Retinal fundus photograph; FOV: 45 degrees; 2352 x 1568 pixels
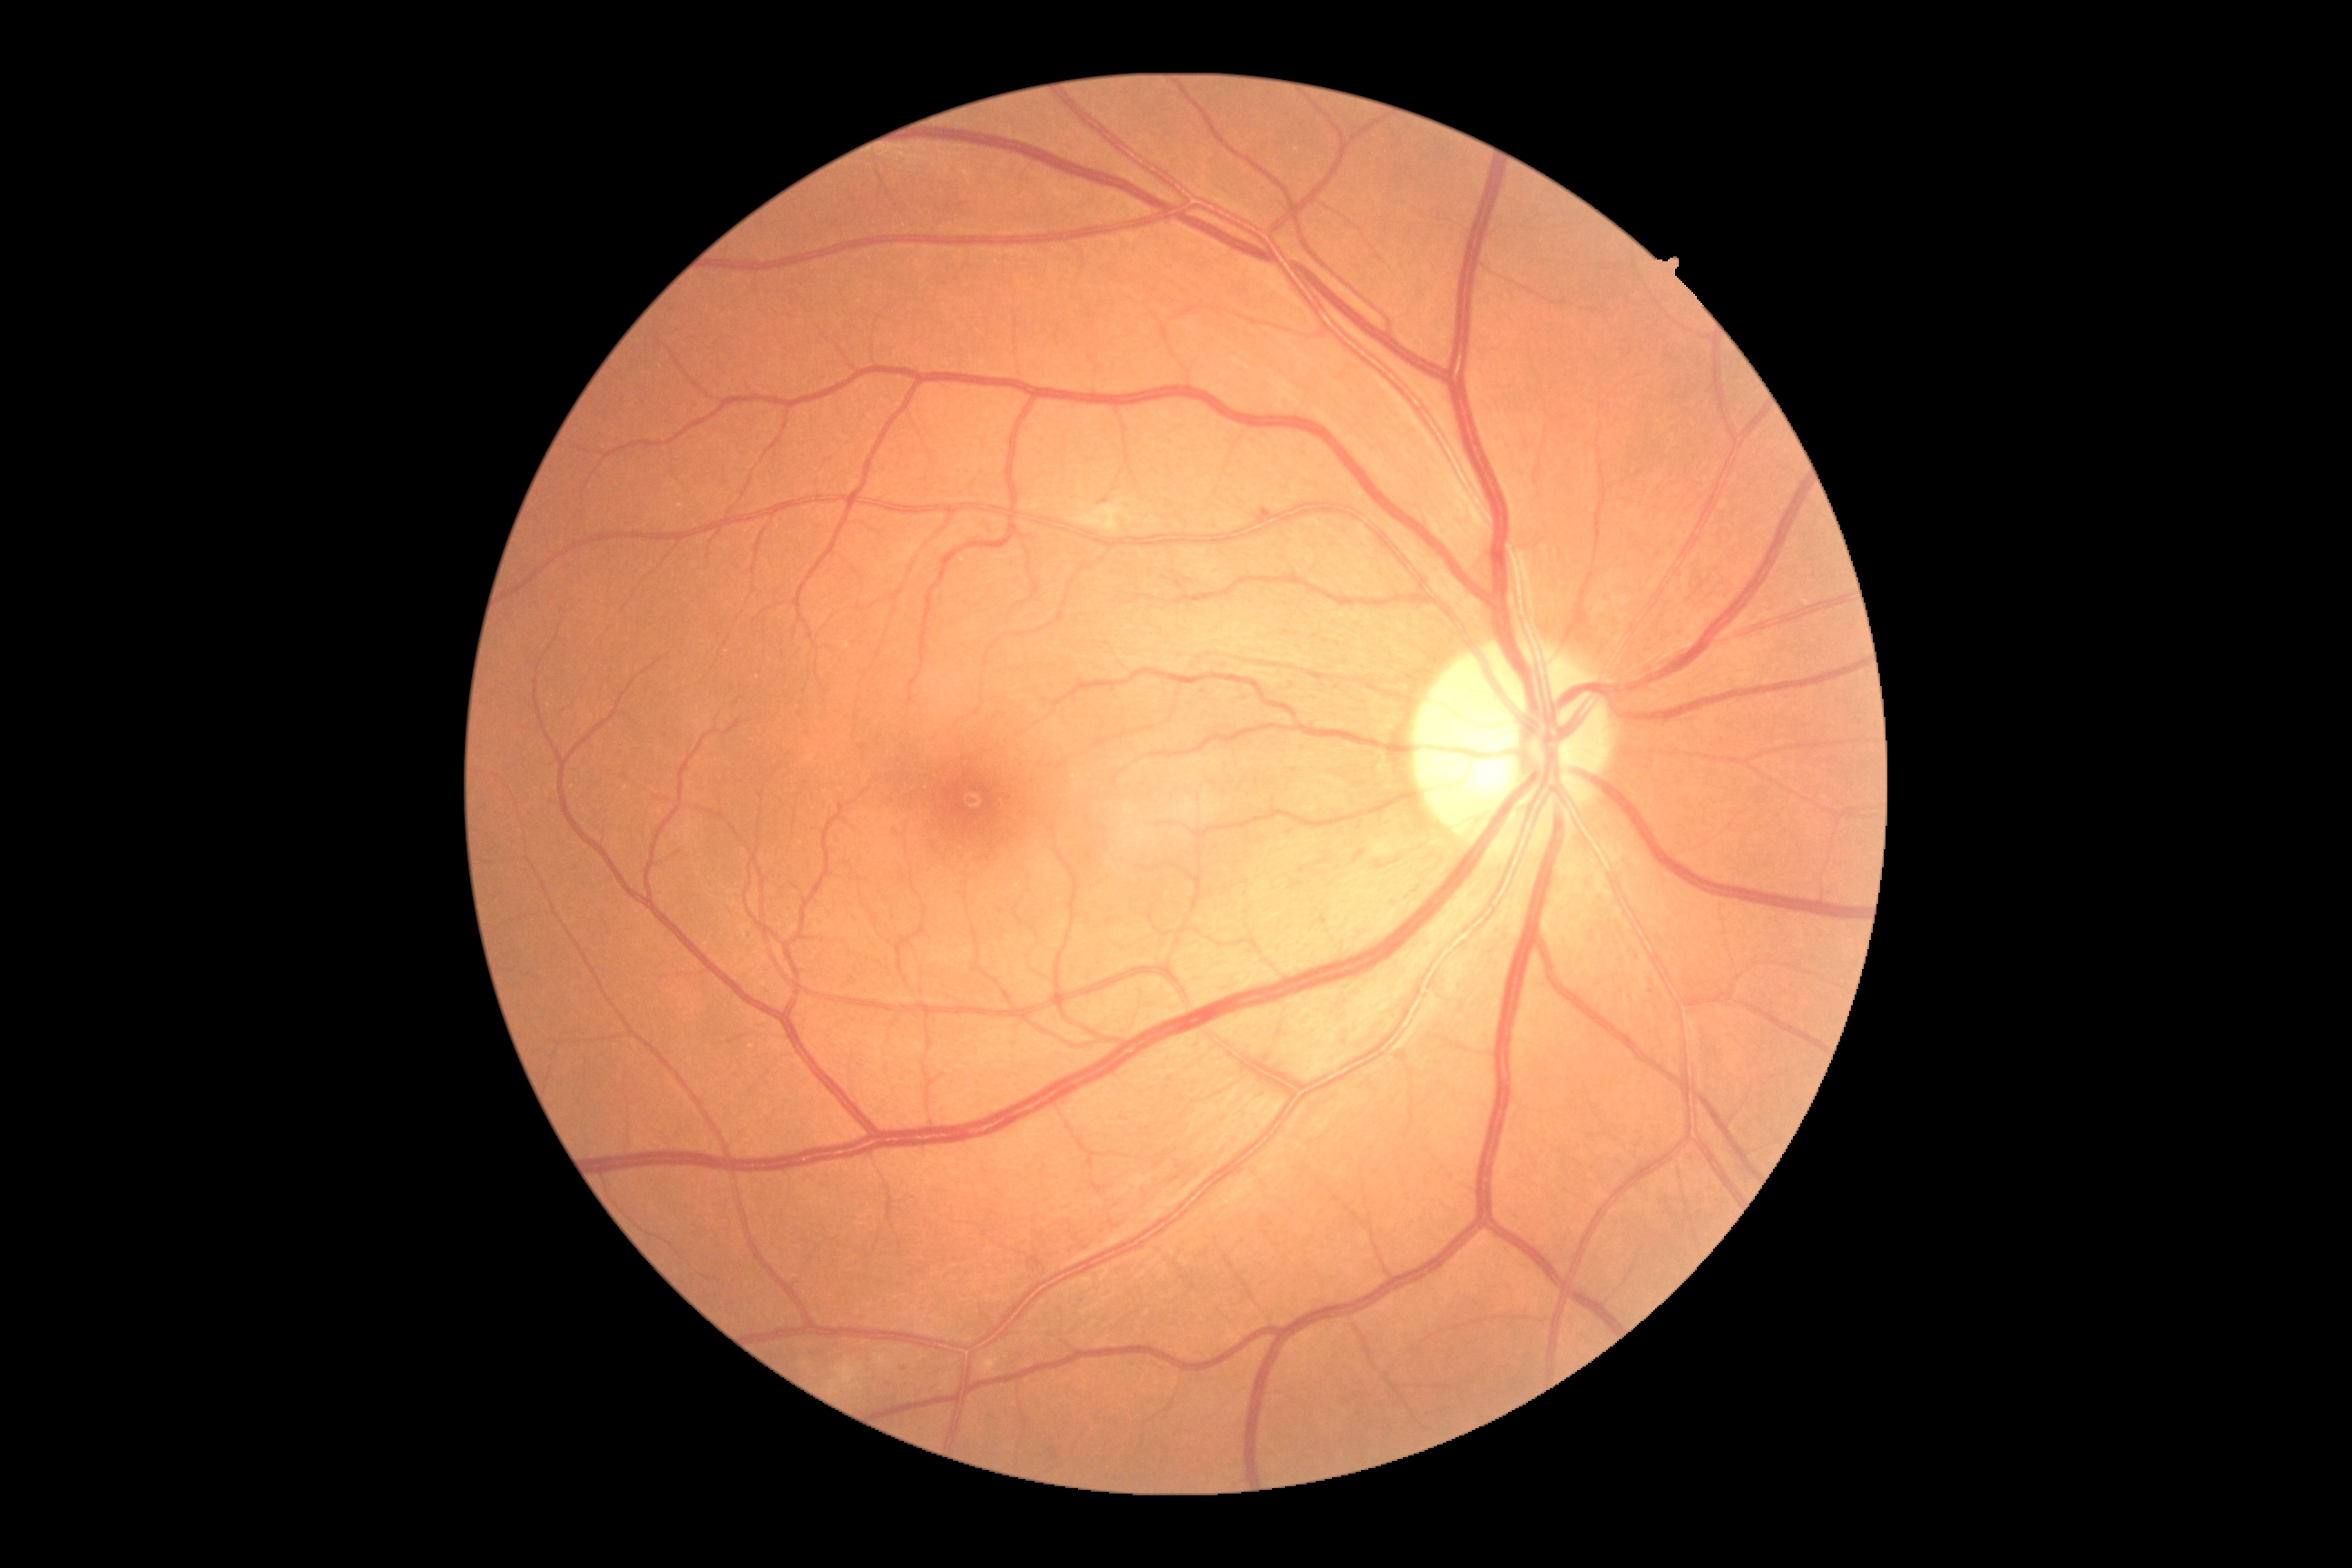

Disease class: non-proliferative diabetic retinopathy.
DR stage is grade 2.